NIDEK AFC-230; color fundus photograph
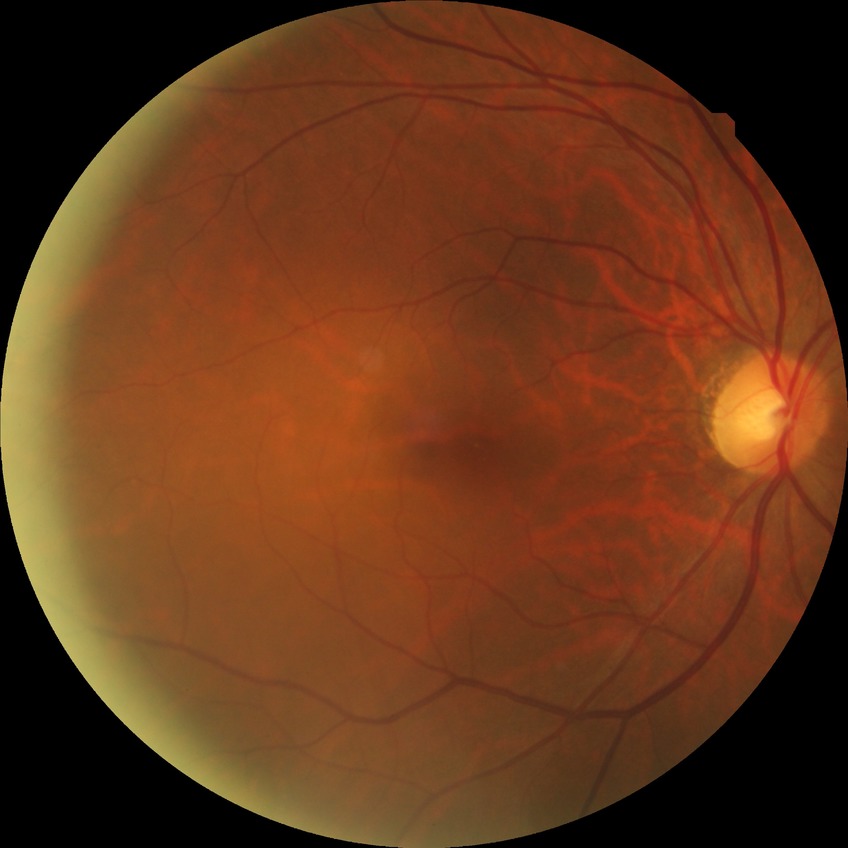 DR grade=NDR, DR impression=no DR findings.